Image size 2346x1568; FOV: 45 degrees; color fundus image:
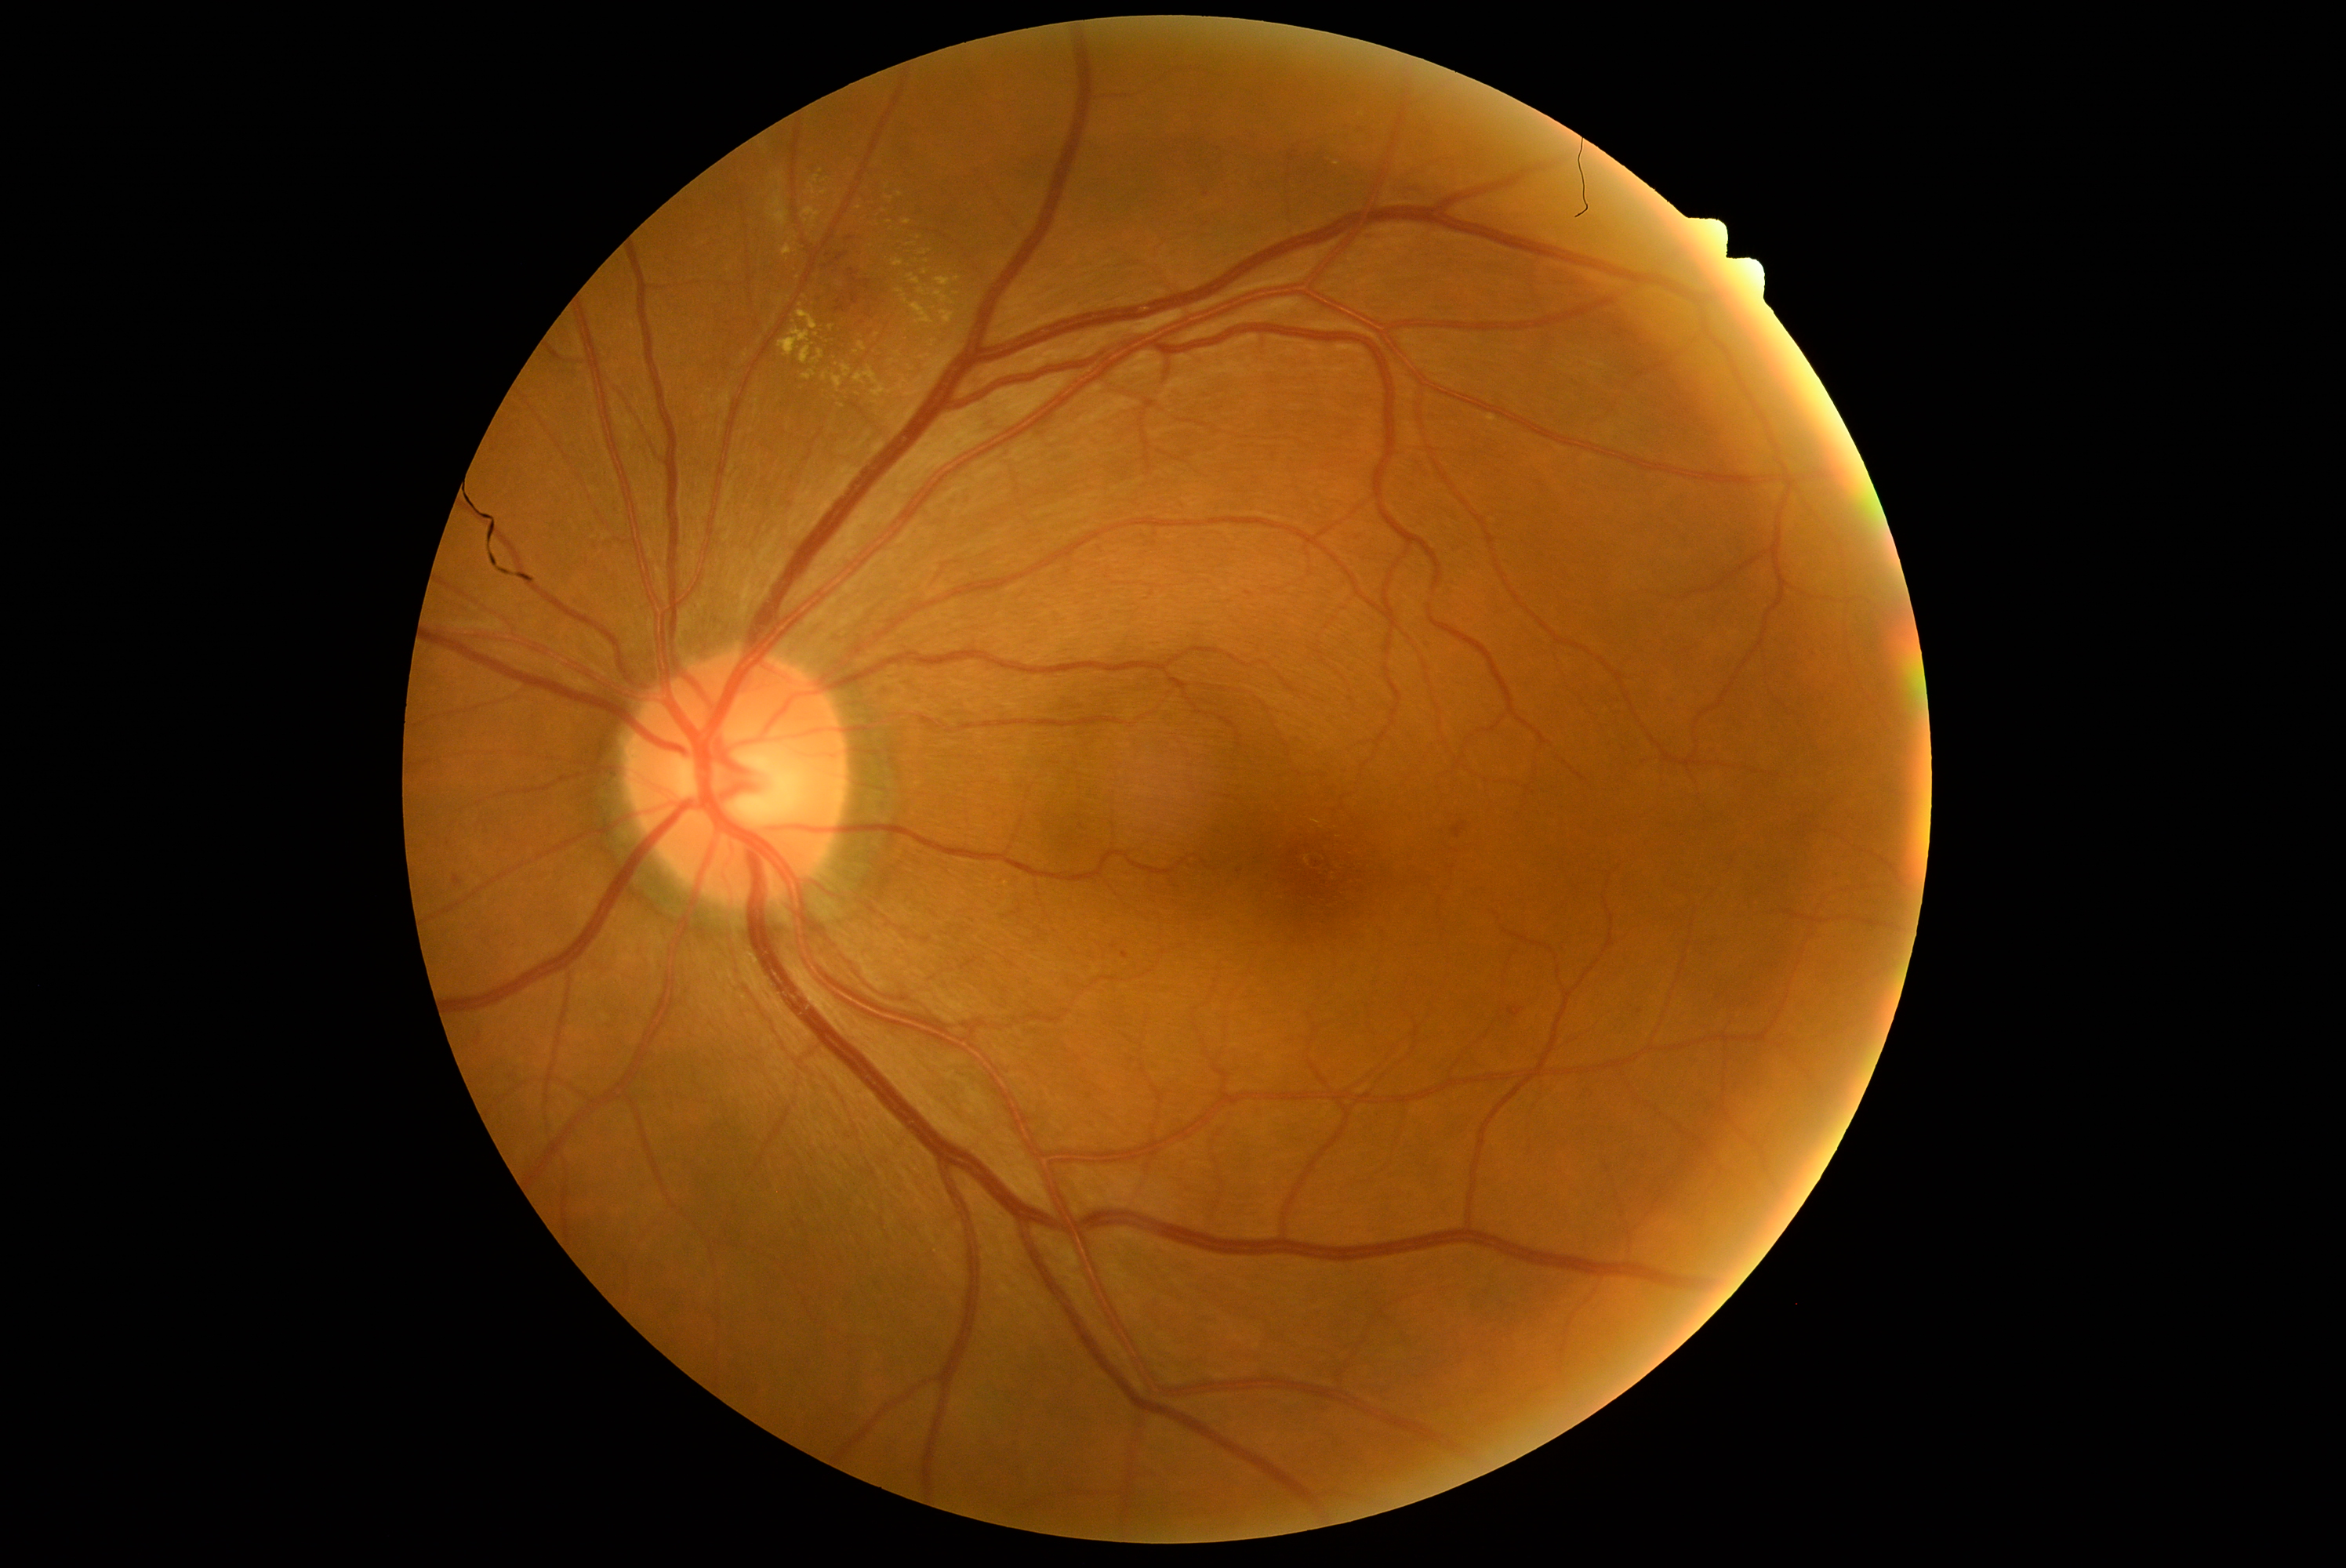 DR stage: 2/4
Representative lesions:
MAs: not present
EXs (subset): x1=918, y1=288, x2=932, y2=297, x1=768, y1=194, x2=790, y2=228, x1=815, y1=176, x2=819, y2=184, x1=854, y1=341, x2=956, y2=399, x1=819, y1=191, x2=827, y2=197, x1=948, y1=407, x2=975, y2=421, x1=1487, y1=415, x2=1497, y2=423, x1=823, y1=372, x2=829, y2=382, x1=935, y1=278, x2=953, y2=288, x1=812, y1=350, x2=824, y2=365, x1=892, y1=260, x2=904, y2=267
Small EXs near (824; 181), (892; 363), (926; 262), (956; 294), (859; 207), (1006; 885), (934; 308)
HEs (subset): x1=1346, y1=531, x2=1365, y2=542, x1=1420, y1=639, x2=1436, y2=648, x1=452, y1=876, x2=462, y2=887, x1=1362, y1=233, x2=1390, y2=242, x1=1120, y1=953, x2=1128, y2=960, x1=1354, y1=128, x2=1367, y2=134, x1=812, y1=252, x2=881, y2=328
Small HEs near (828; 256), (851; 238), (1240; 871), (1249; 594)
SEs: not present